2212x1659px:
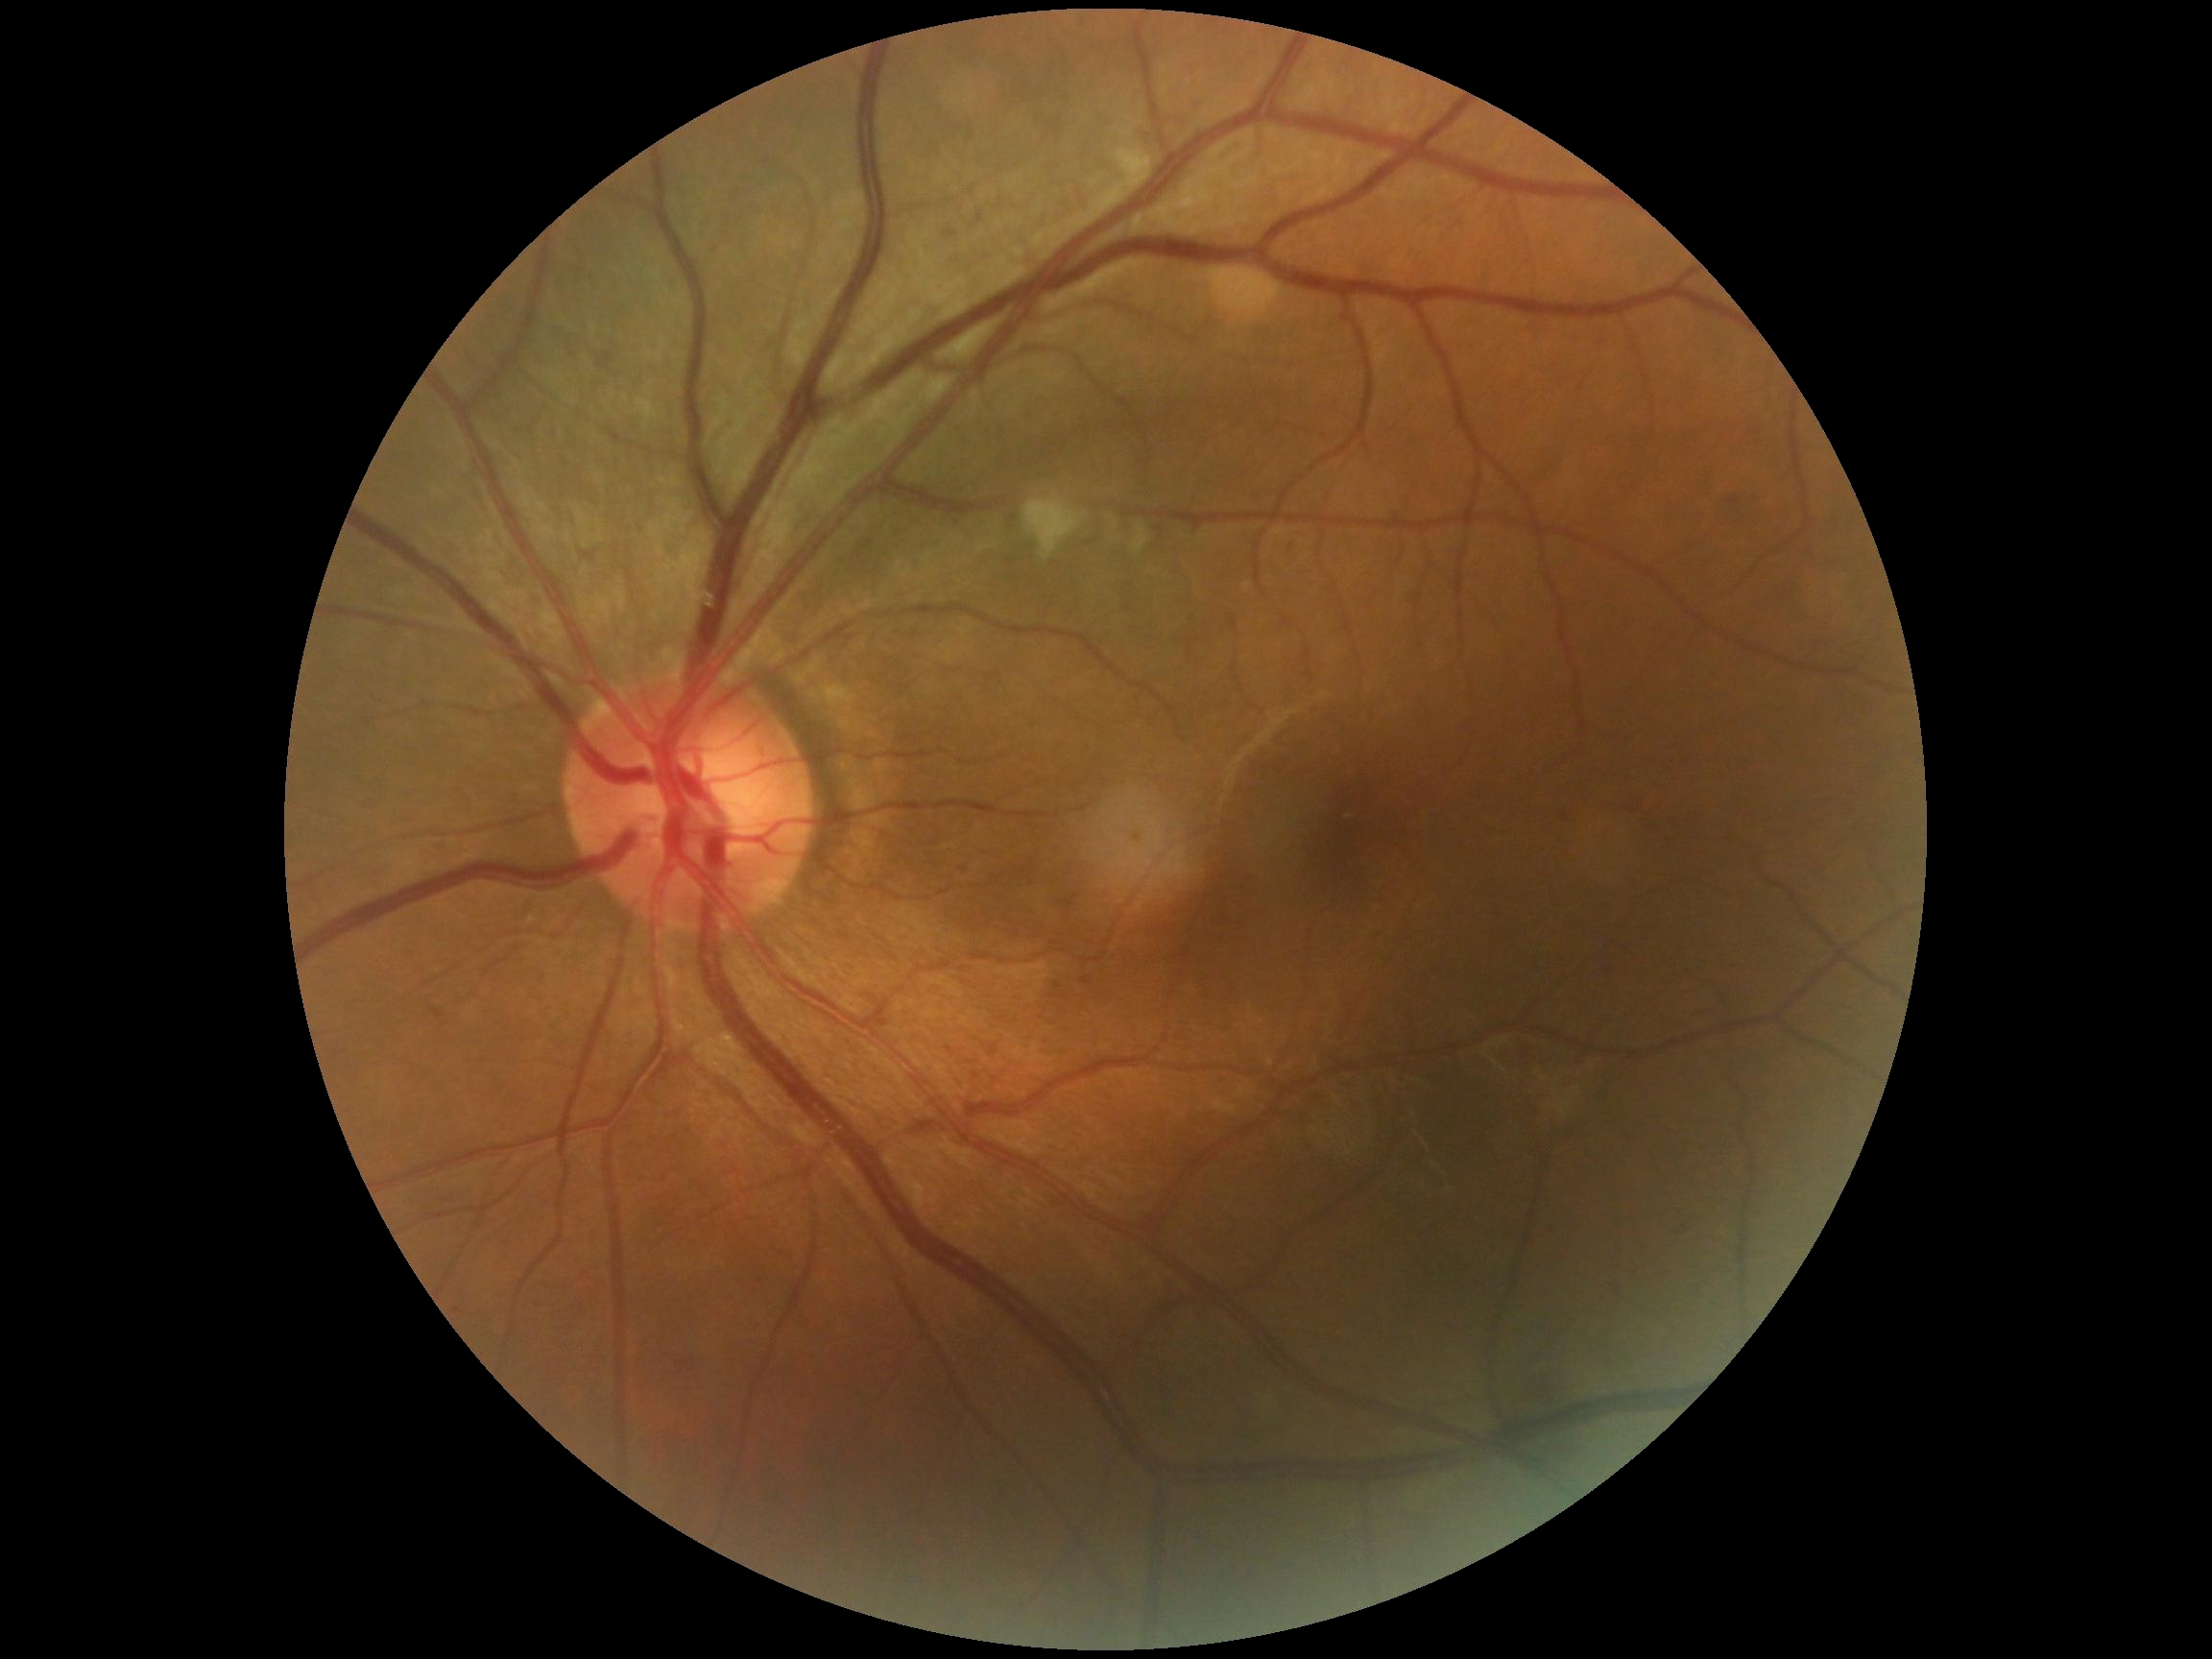
diabetic retinopathy (DR) = 2